Modified Davis classification: 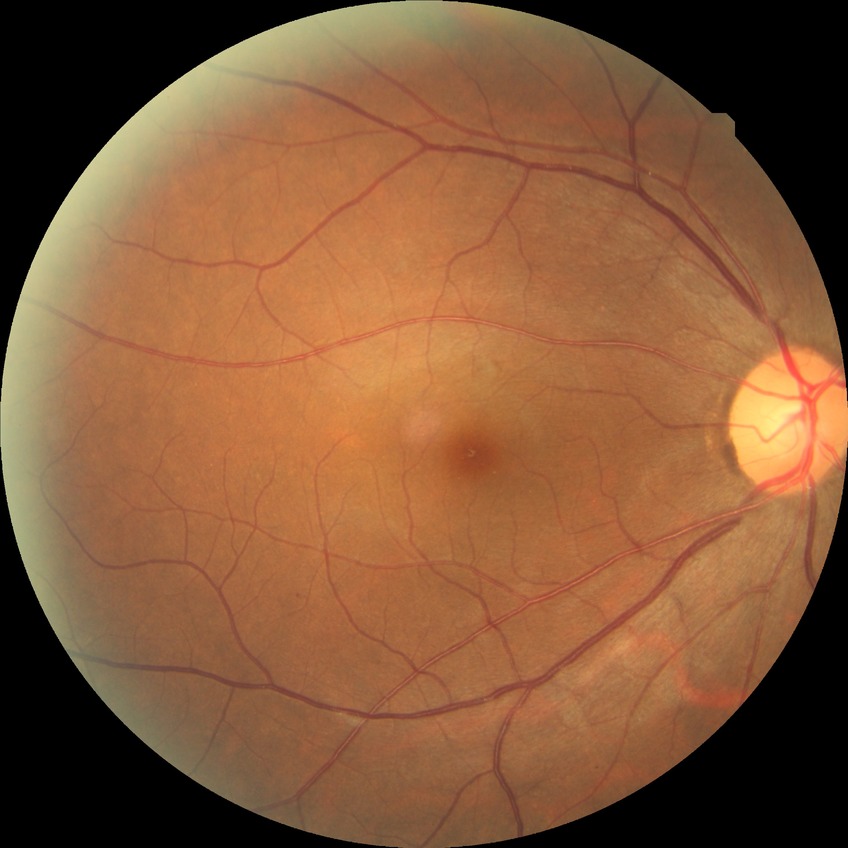

Diabetic retinopathy (DR): NDR (no diabetic retinopathy).